1924x1556 · color fundus photograph.
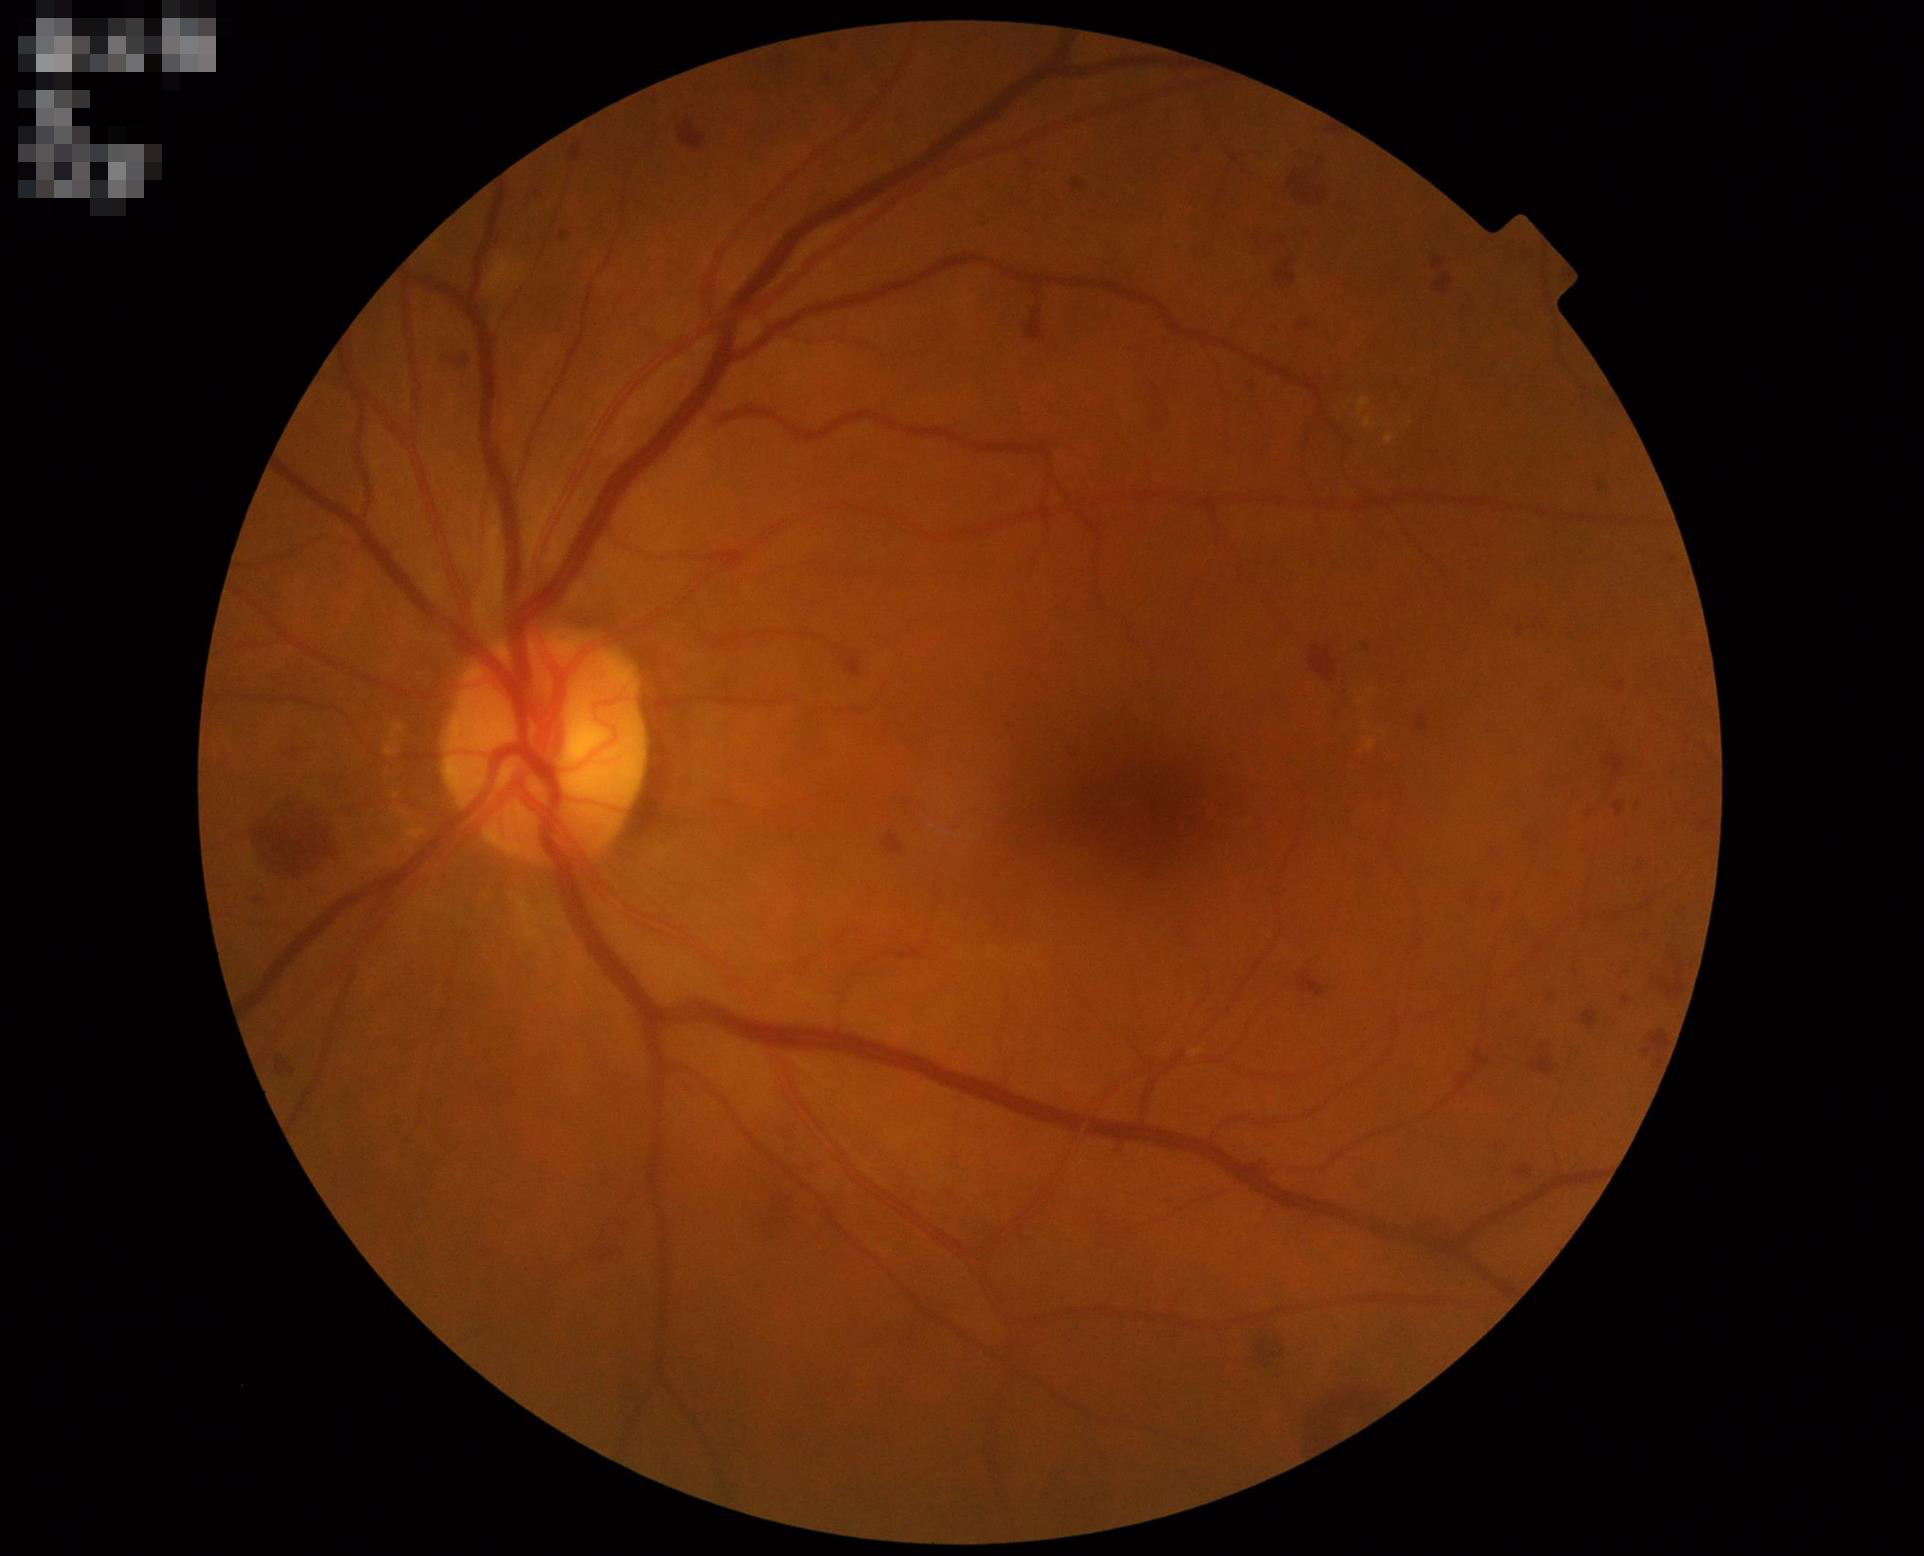 Overall image quality is good. Illumination and color balance are good.